848 by 848 pixels · 45 degree fundus photograph · camera: NIDEK AFC-230 · no pharmacologic dilation
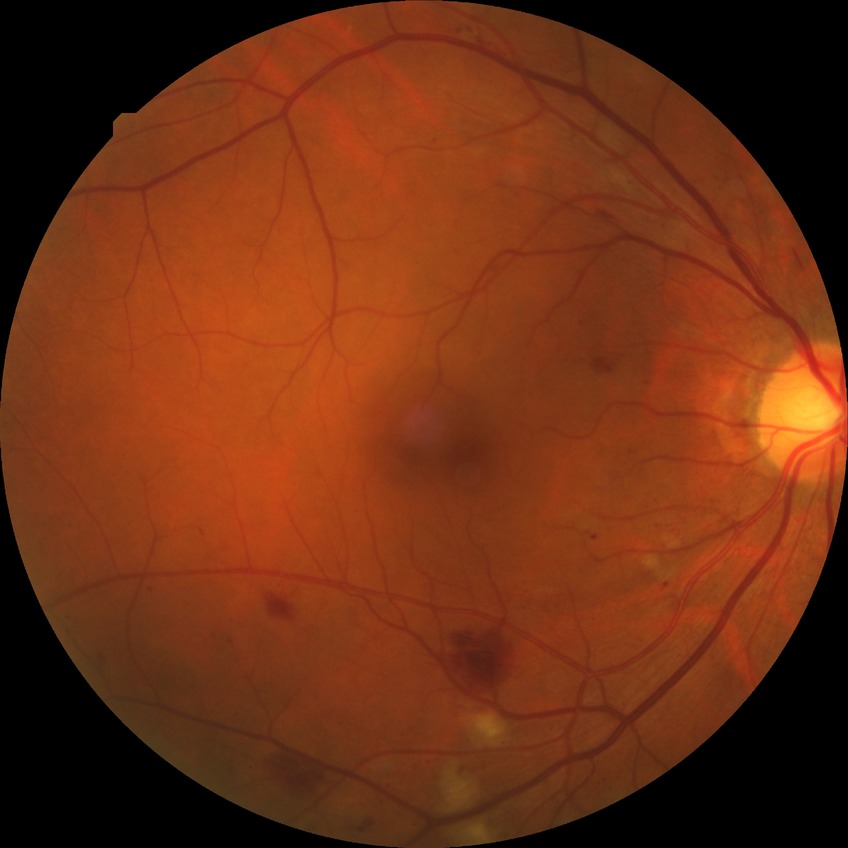
Findings:
- DR class: non-proliferative diabetic retinopathy
- DR: PPDR